Color fundus photograph · 2089 by 1764 pixels
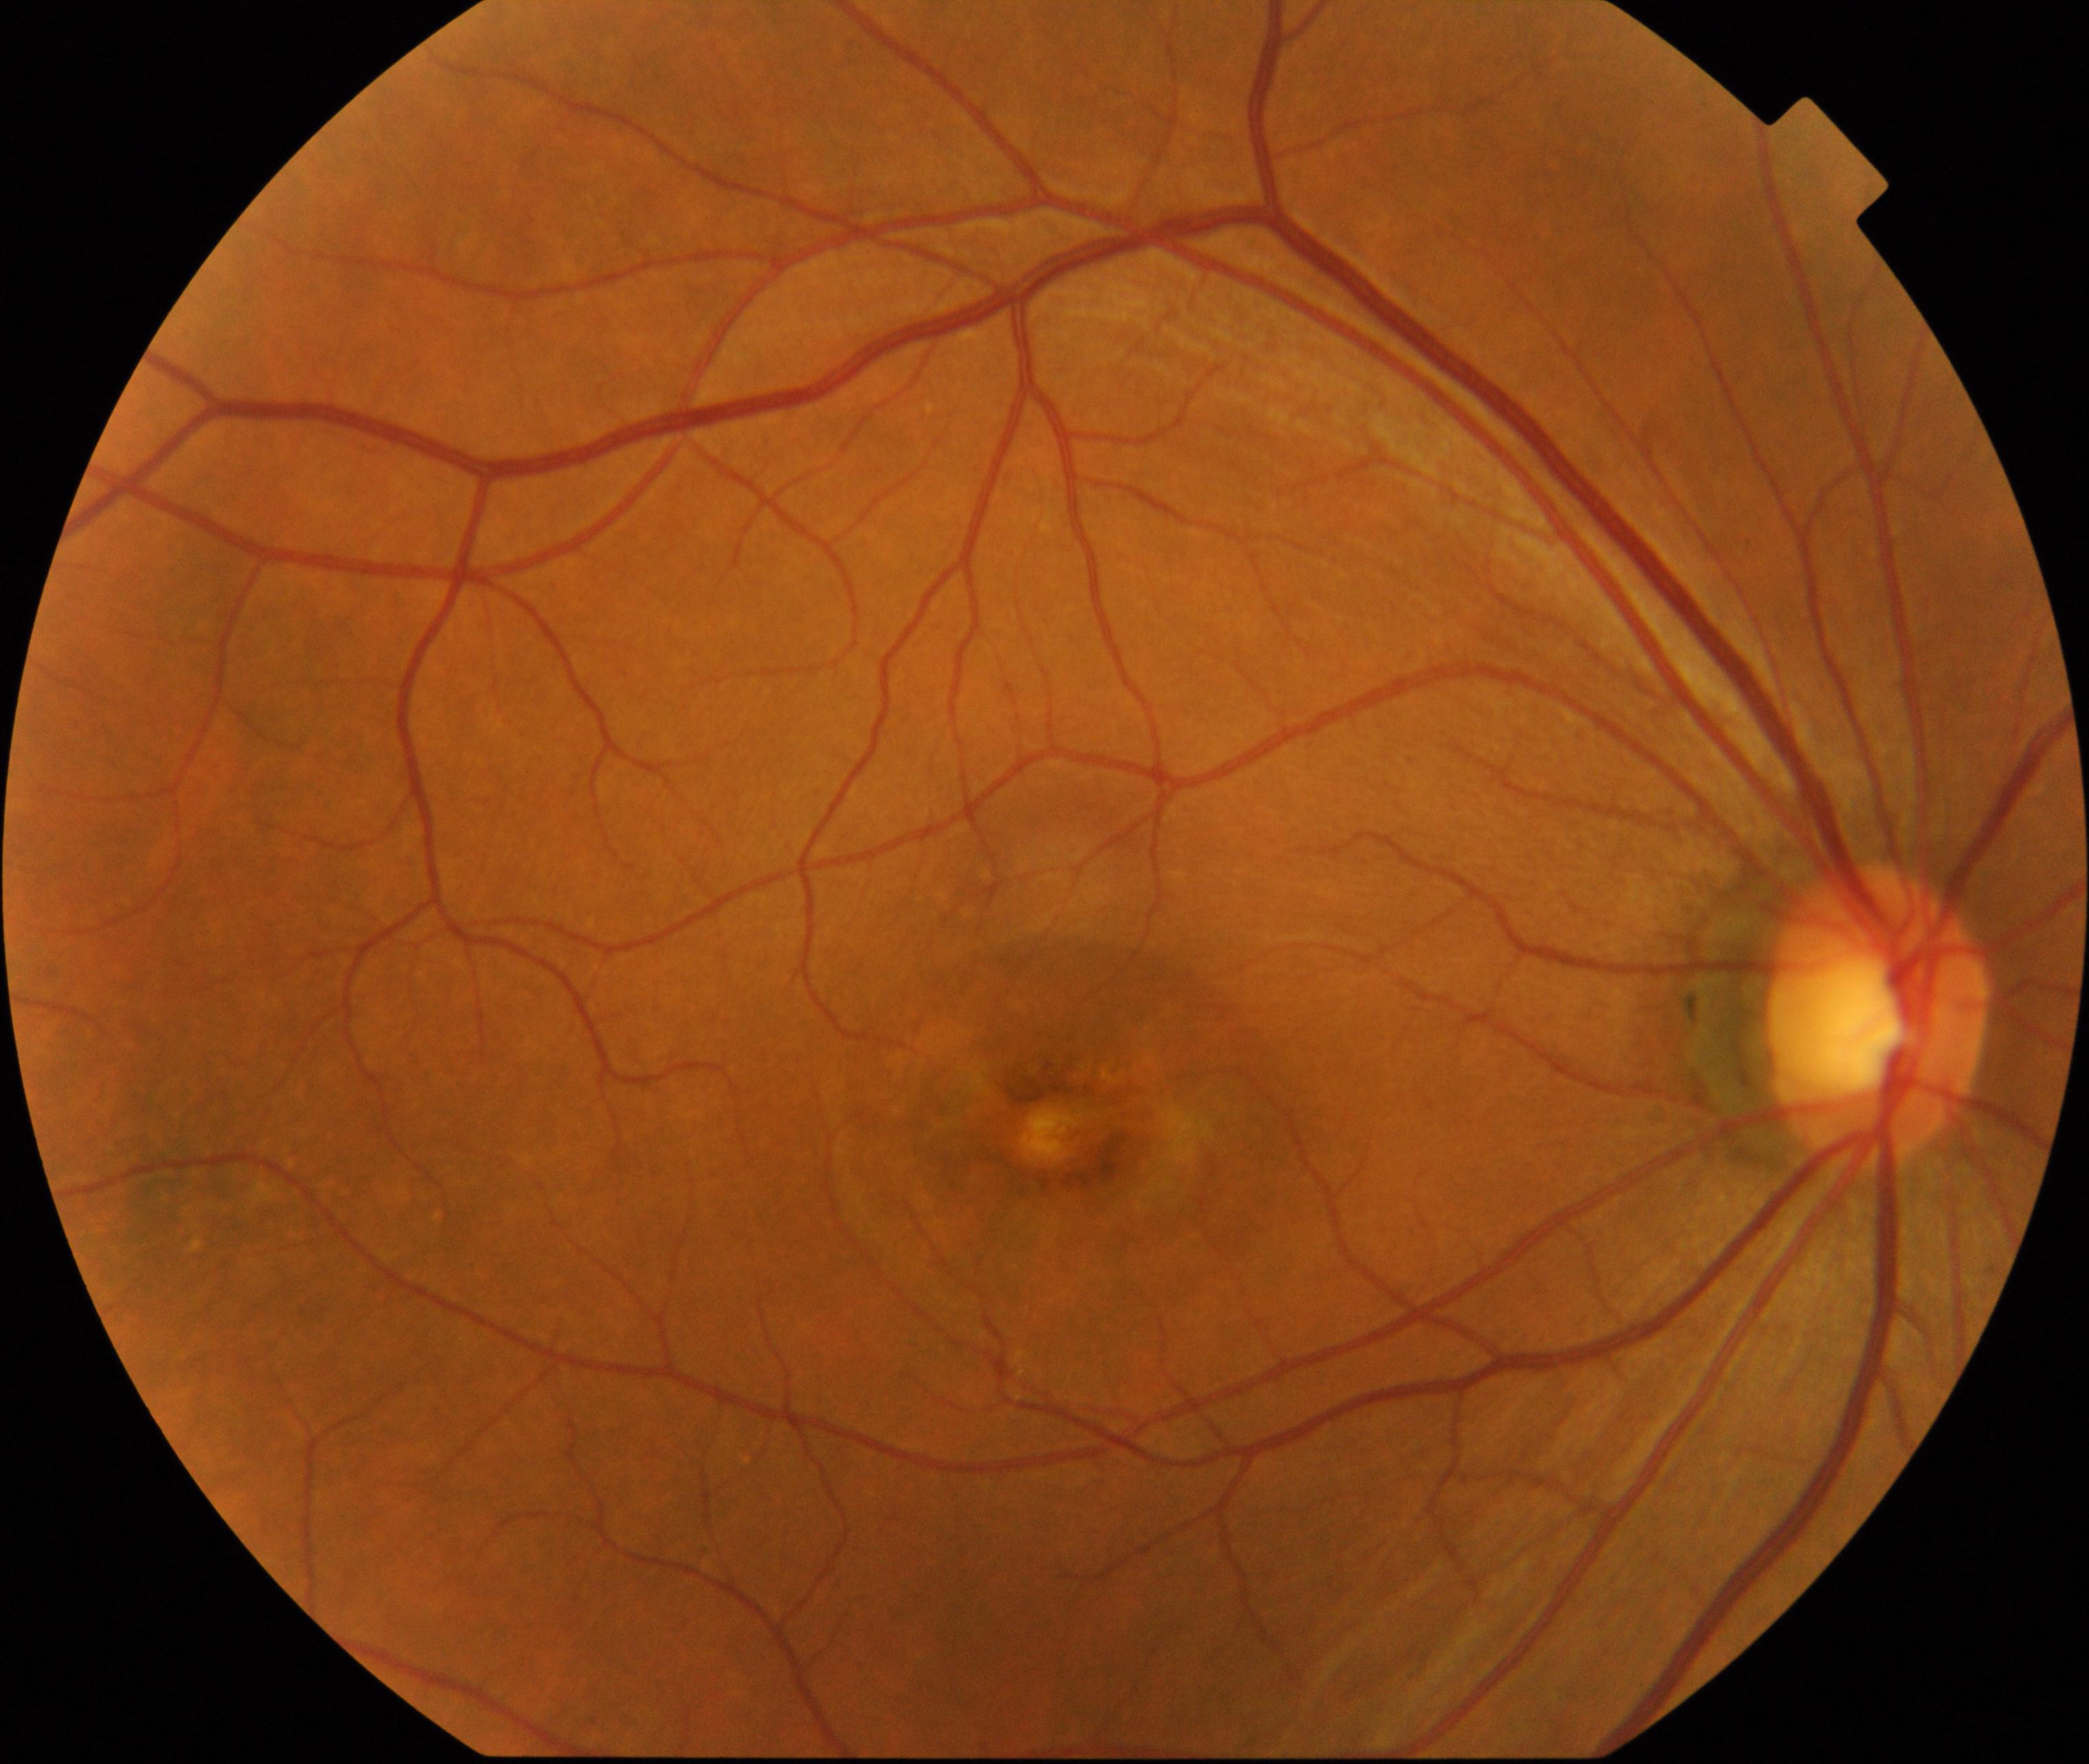 Findings consistent with maculopathy.